CFP · 2352 x 1568 pixels — 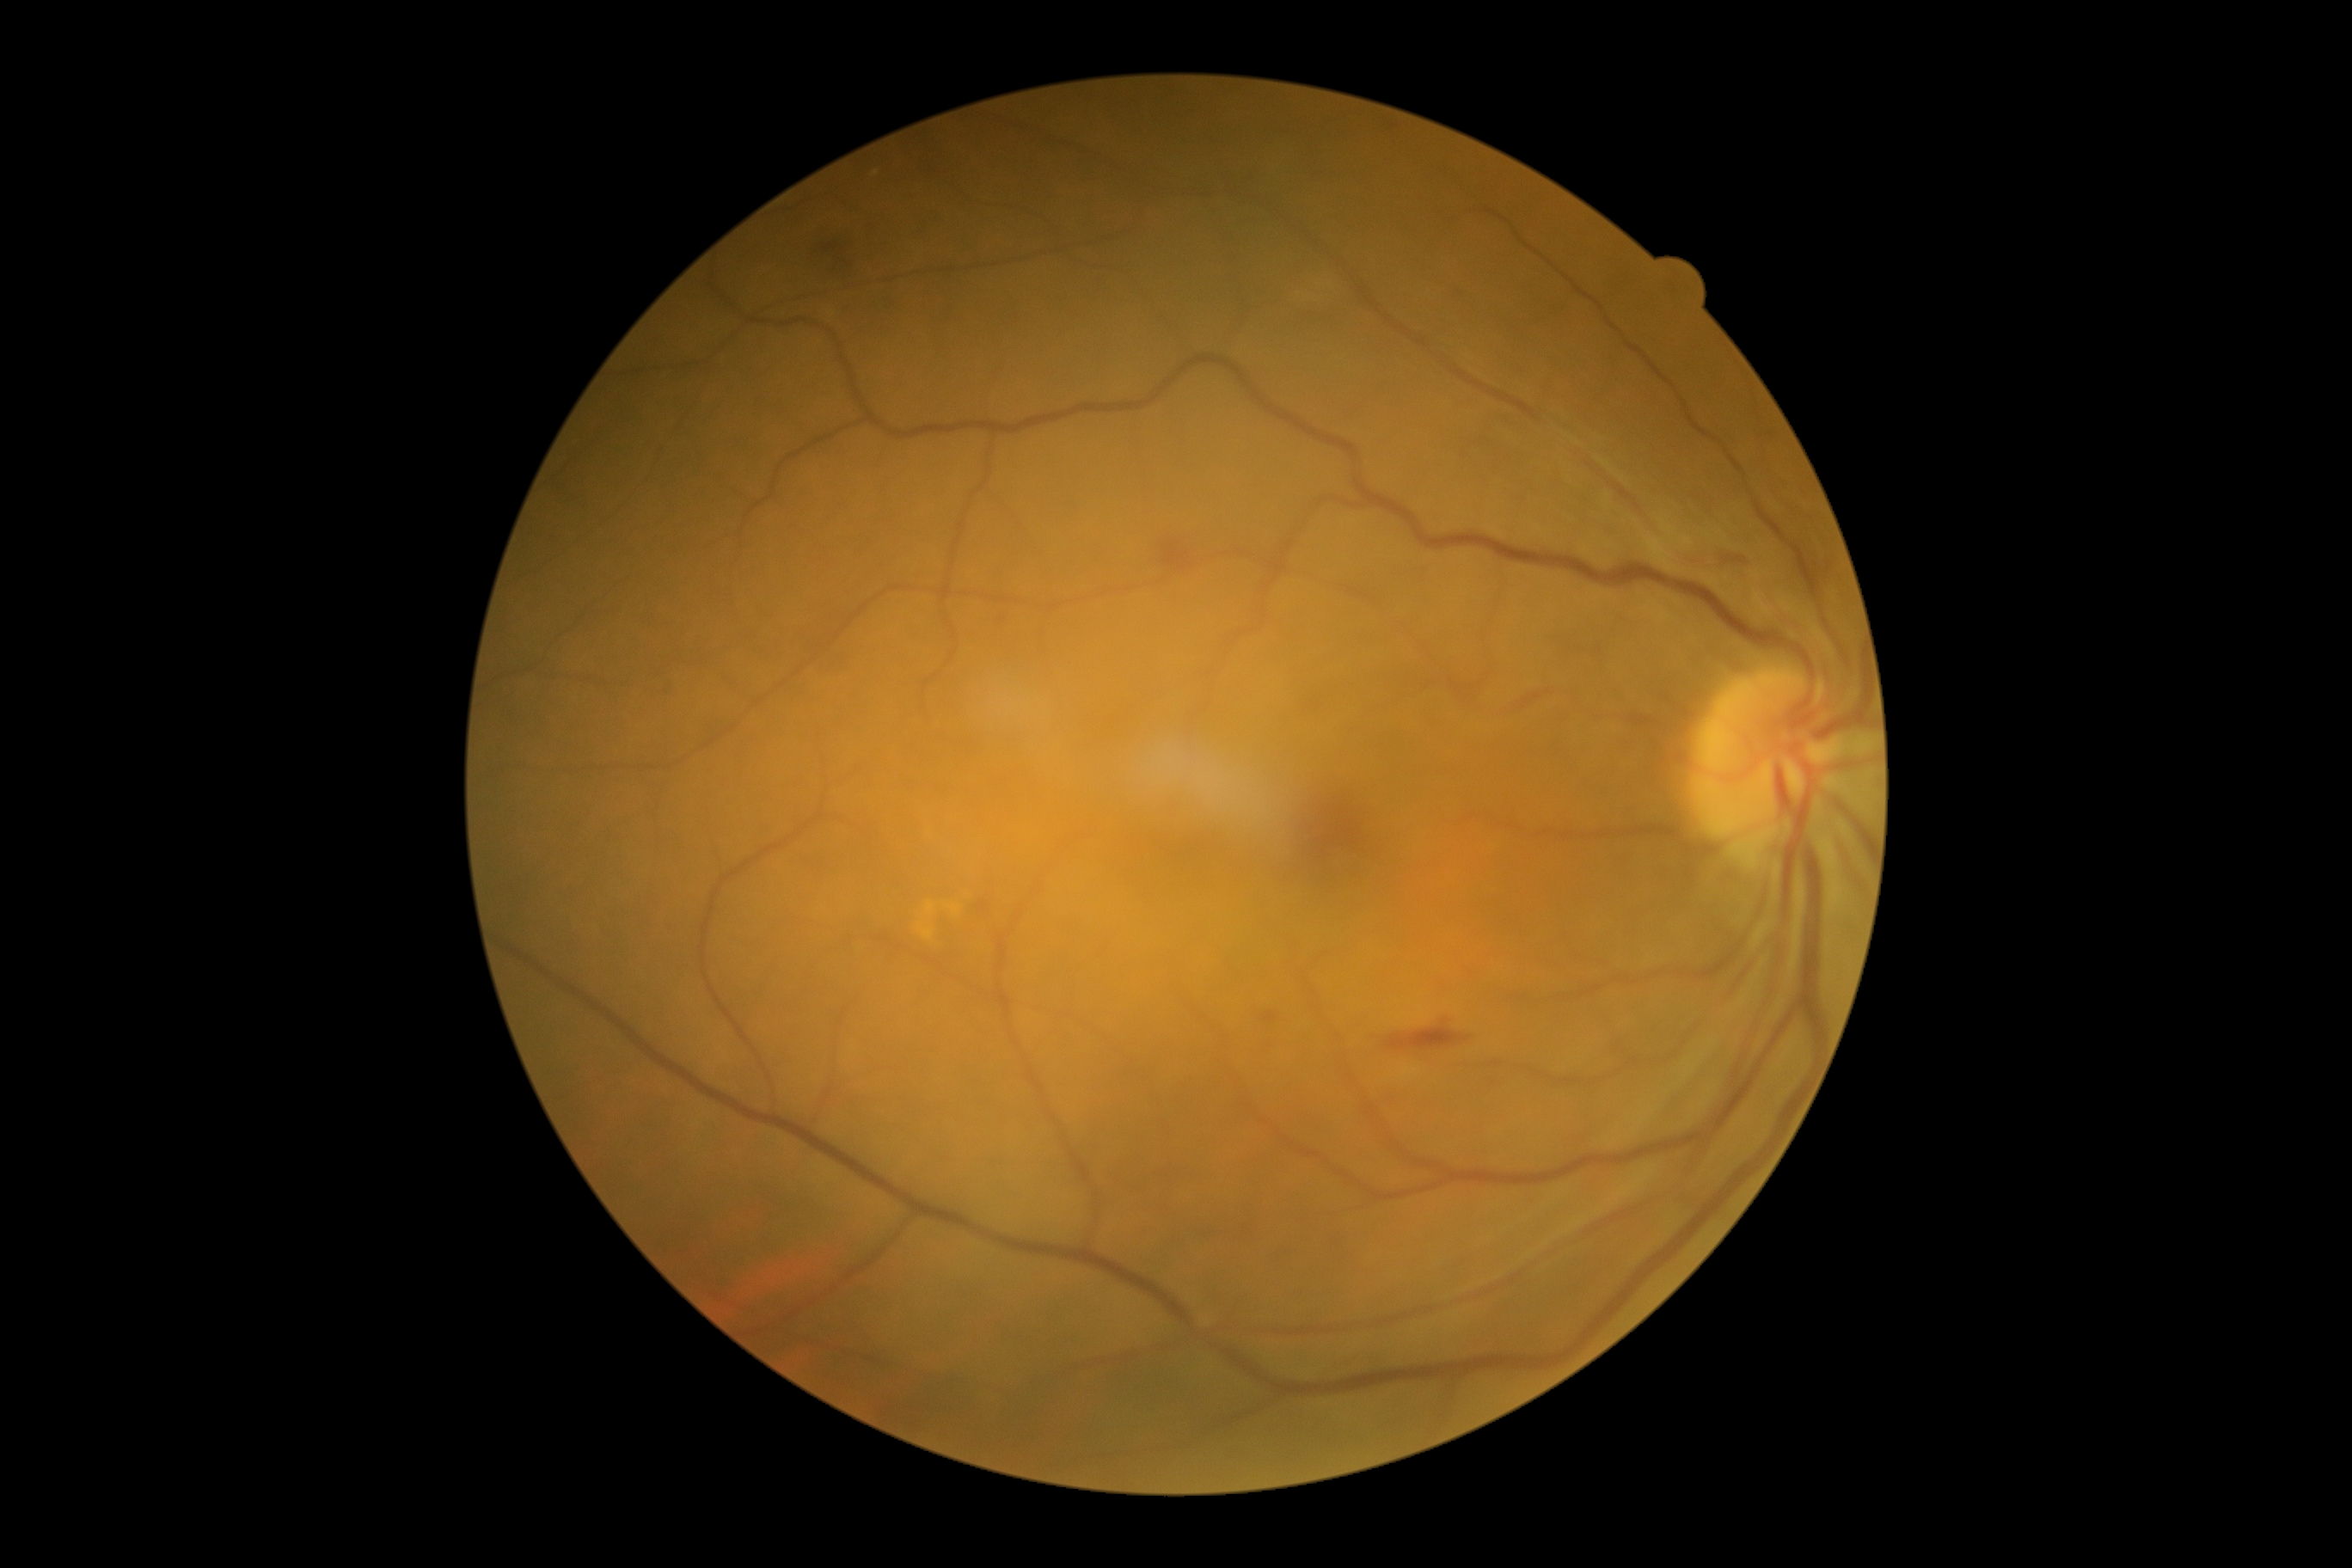 dr_grade: 2
dr_grade_name: moderate NPDR
lesions:
  se: []
  he:
    - <box>1385,1020,1471,1051</box>
    - <box>809,216,852,293</box>
    - <box>1163,542,1192,572</box>
    - <box>1265,1014,1275,1022</box>
    - <box>1675,544,1760,577</box>
  ex: []
  ma:
    - <box>996,613,1008,625</box>